2352x1568 · retinal fundus photograph:
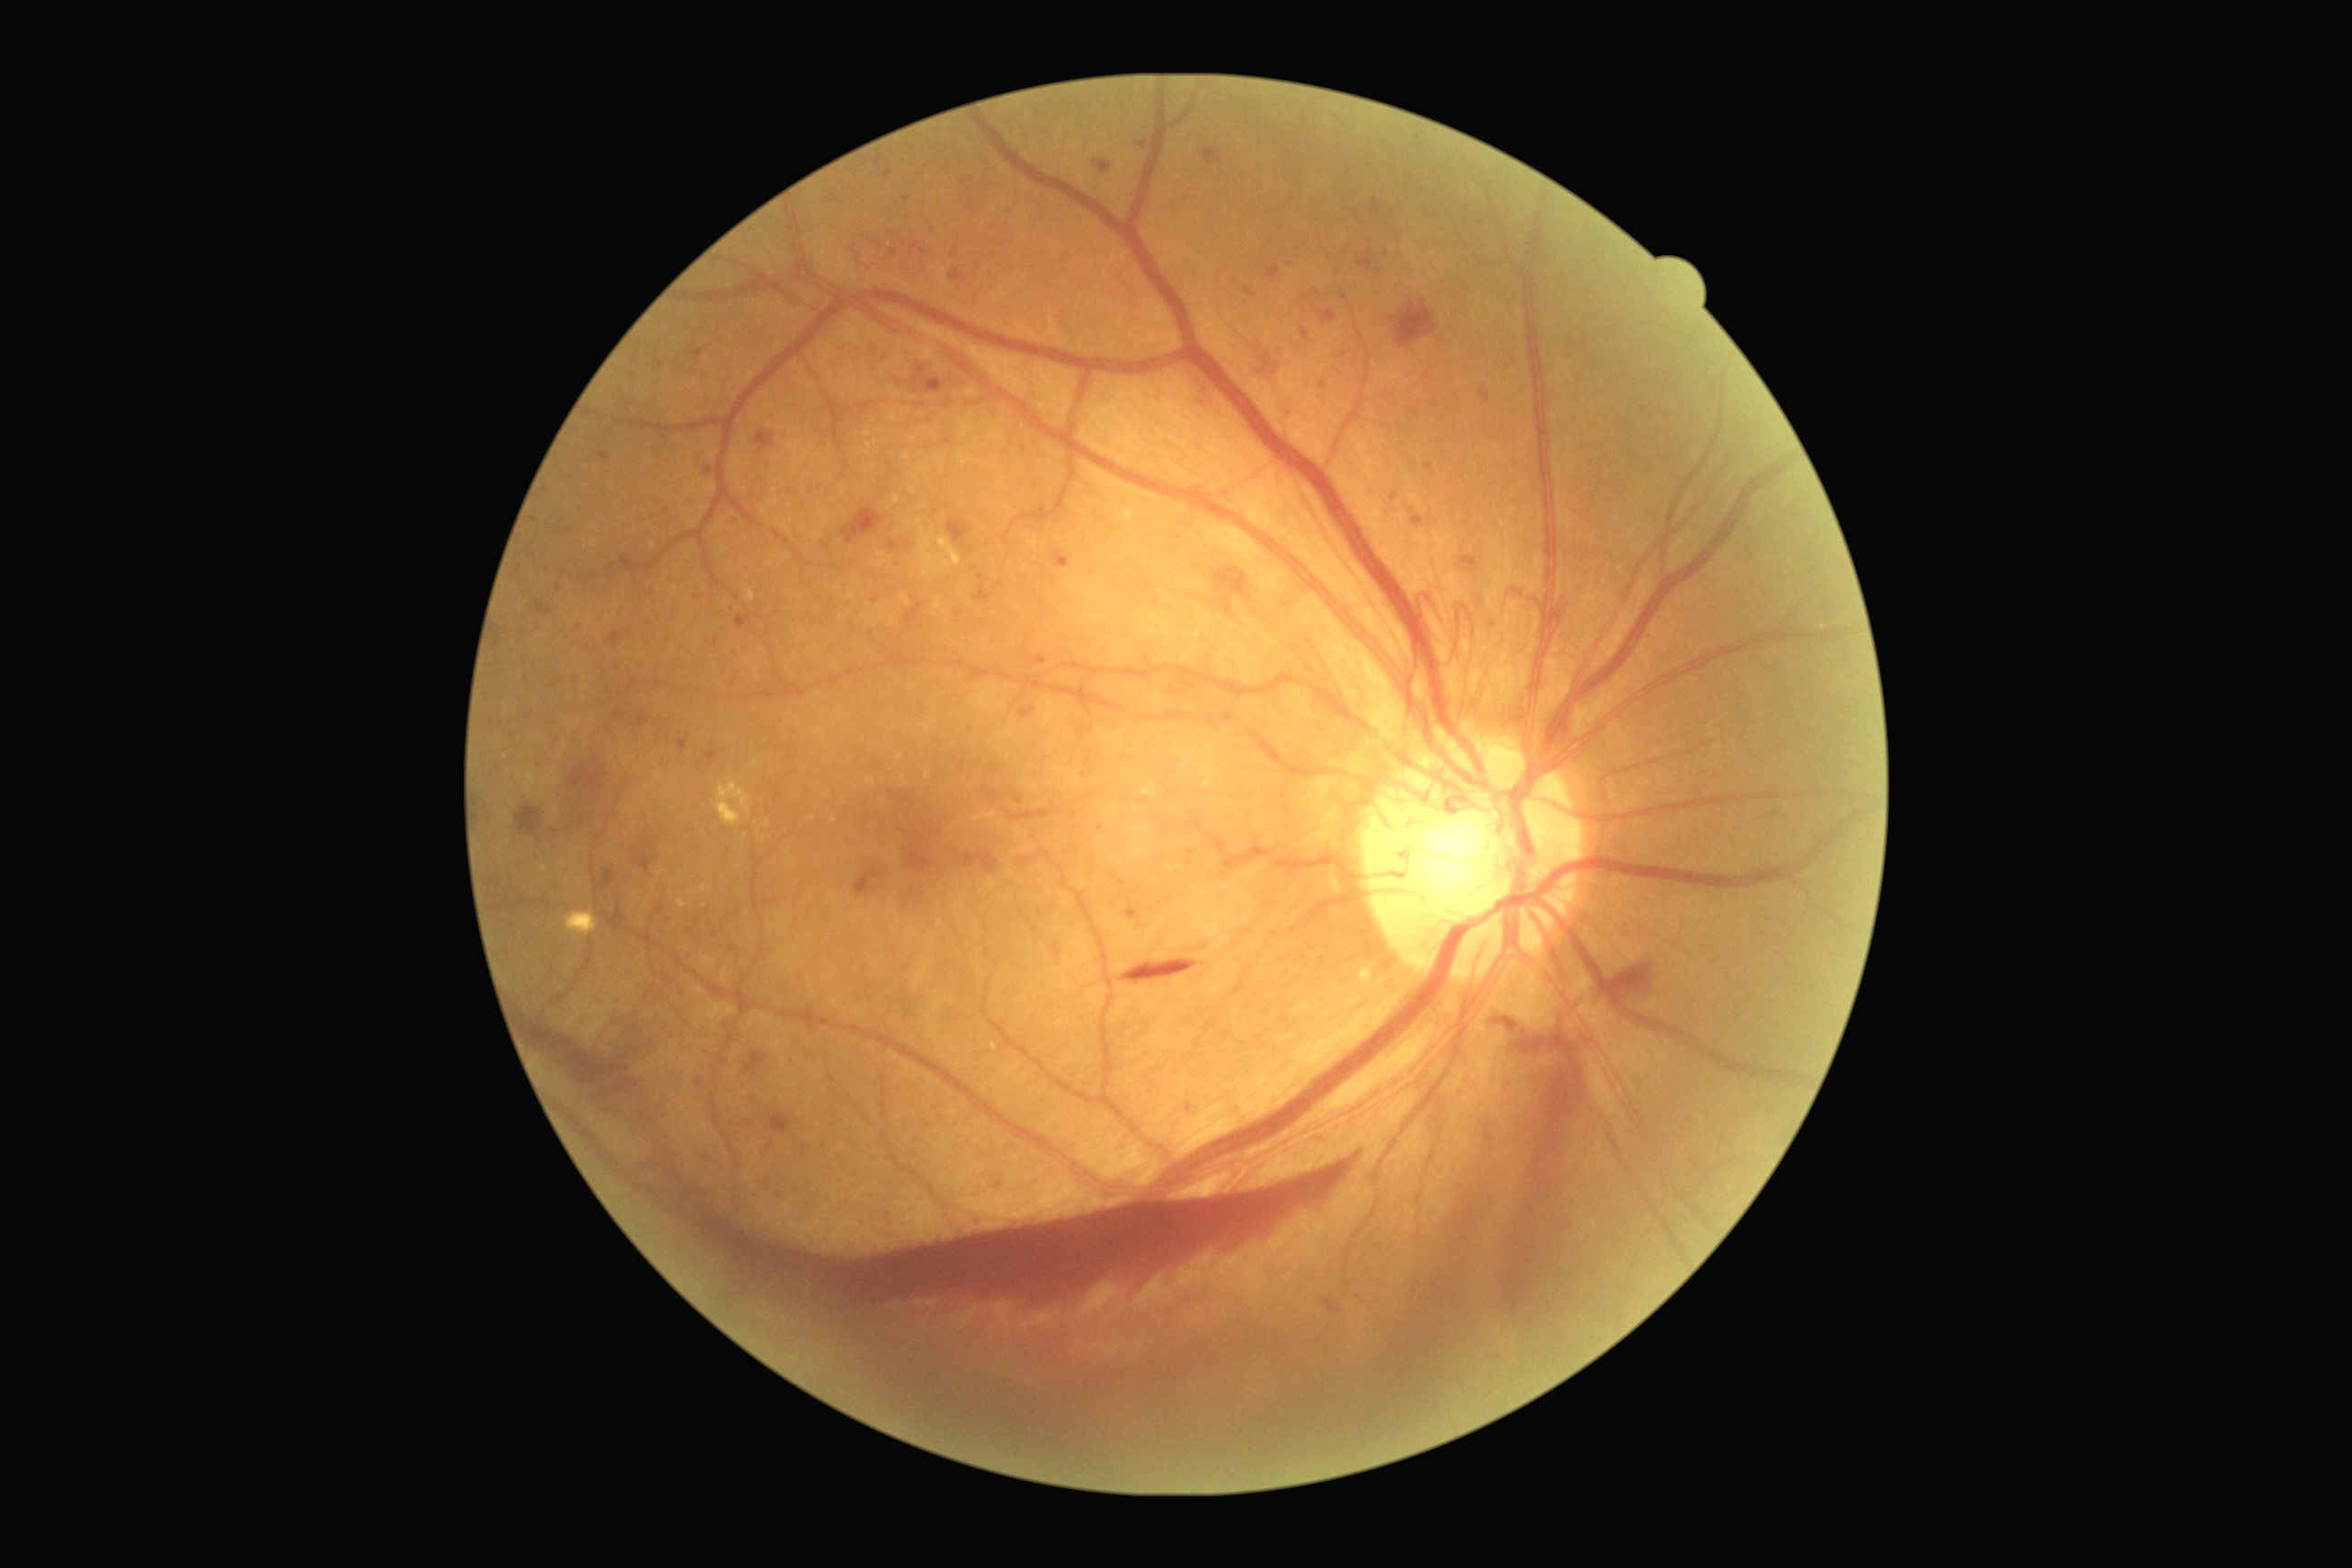 Diabetic retinopathy grade: proliferative diabetic retinopathy (4)
A subset of detected lesions:
soft exudates: not present
hemorrhages (more not shown): 1765 814 1776 819 | 1014 810 1054 821 | 1195 377 1217 411 | 1054 553 1072 569 | 883 525 912 565 | 1494 1015 1529 1034 | 1204 148 1224 166 | 594 870 616 892 | 573 1112 1353 1322 | 974 574 994 603 | 1391 299 1438 349 | 1480 386 1491 406 | 741 1052 769 1077 | 516 807 547 838 | 495 629 502 651 | 983 789 999 803 | 856 867 885 896 | 524 995 669 1173 | 1607 963 1661 999
hard exudates: 716 783 750 825
microaneurysms (more not shown): 623 558 636 569 | 1373 199 1382 217 | 1268 266 1282 280 | 736 614 754 629 | 612 710 625 720 | 1139 142 1148 148 | 634 854 658 874 | 1426 462 1435 471 | 1355 211 1360 219 | 556 585 562 593 | 852 246 861 260
Small microaneurysms approximately at <point>1291, 265</point> | <point>913, 247</point> | <point>579, 628</point> | <point>924, 253</point> | <point>487, 697</point>